2352 x 1568 pixels, CFP — 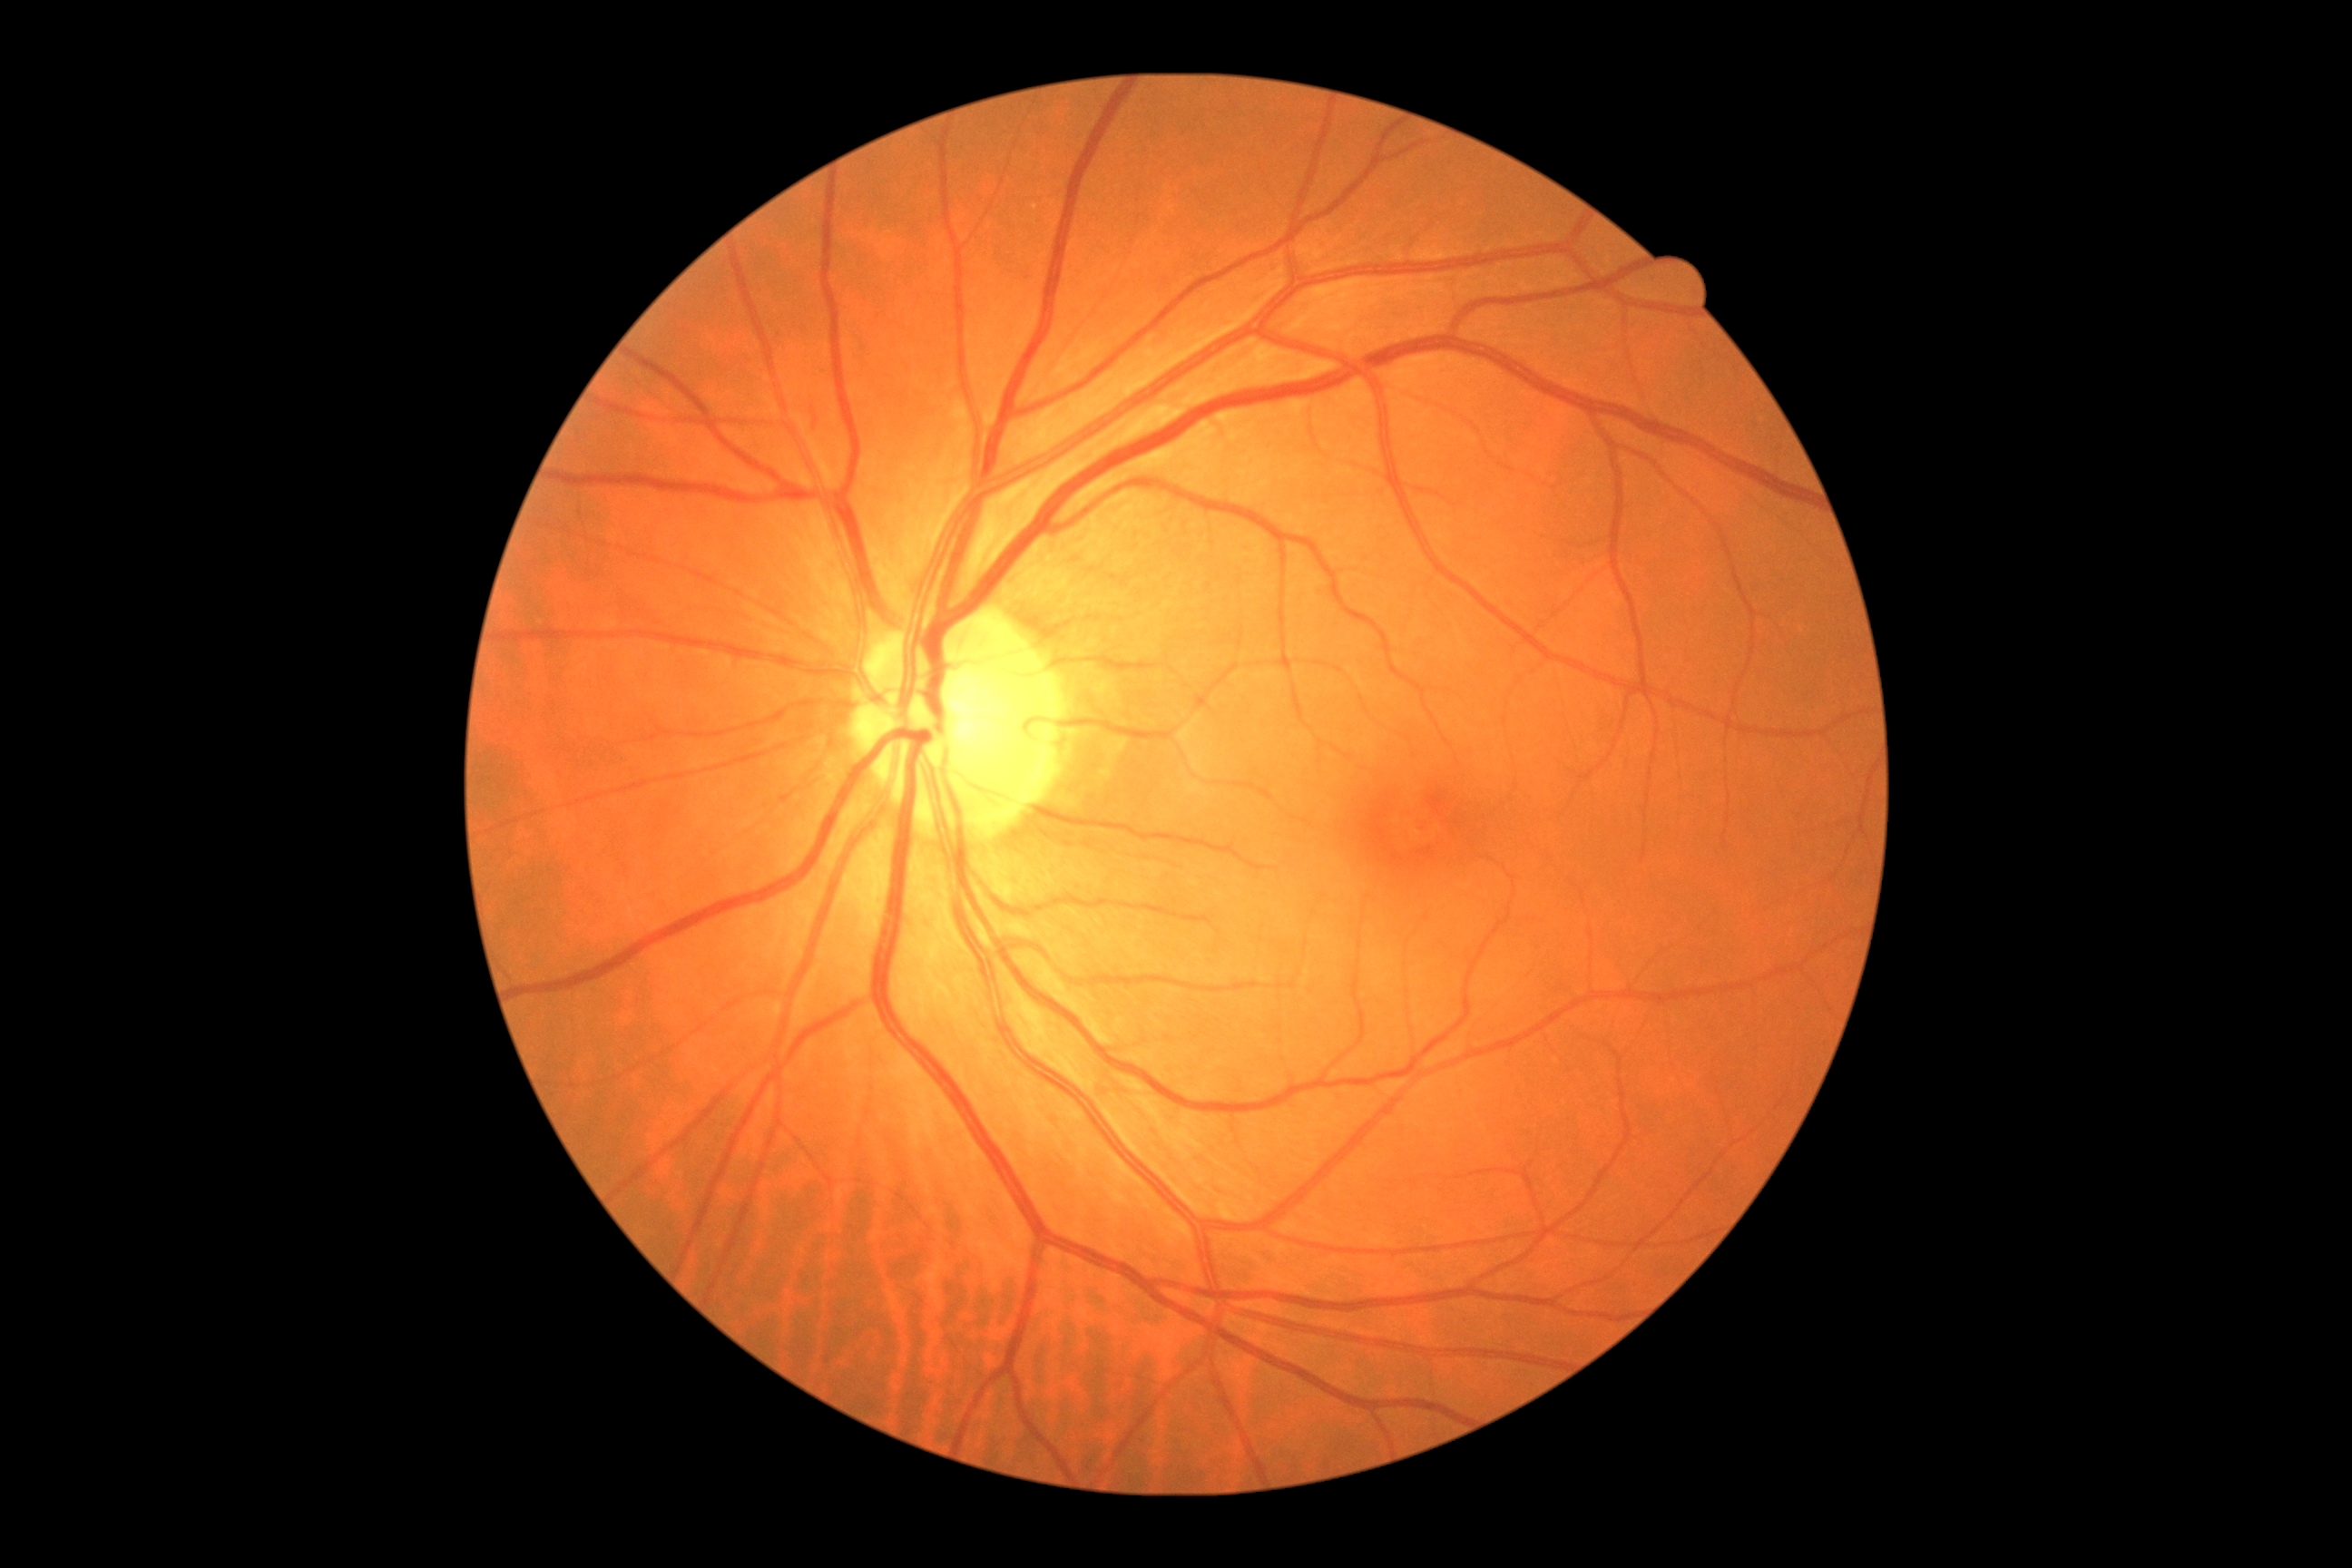

DR impression: no DR findings, retinopathy grade: no apparent retinopathy (0).